2048x1536px · 45-degree field of view.
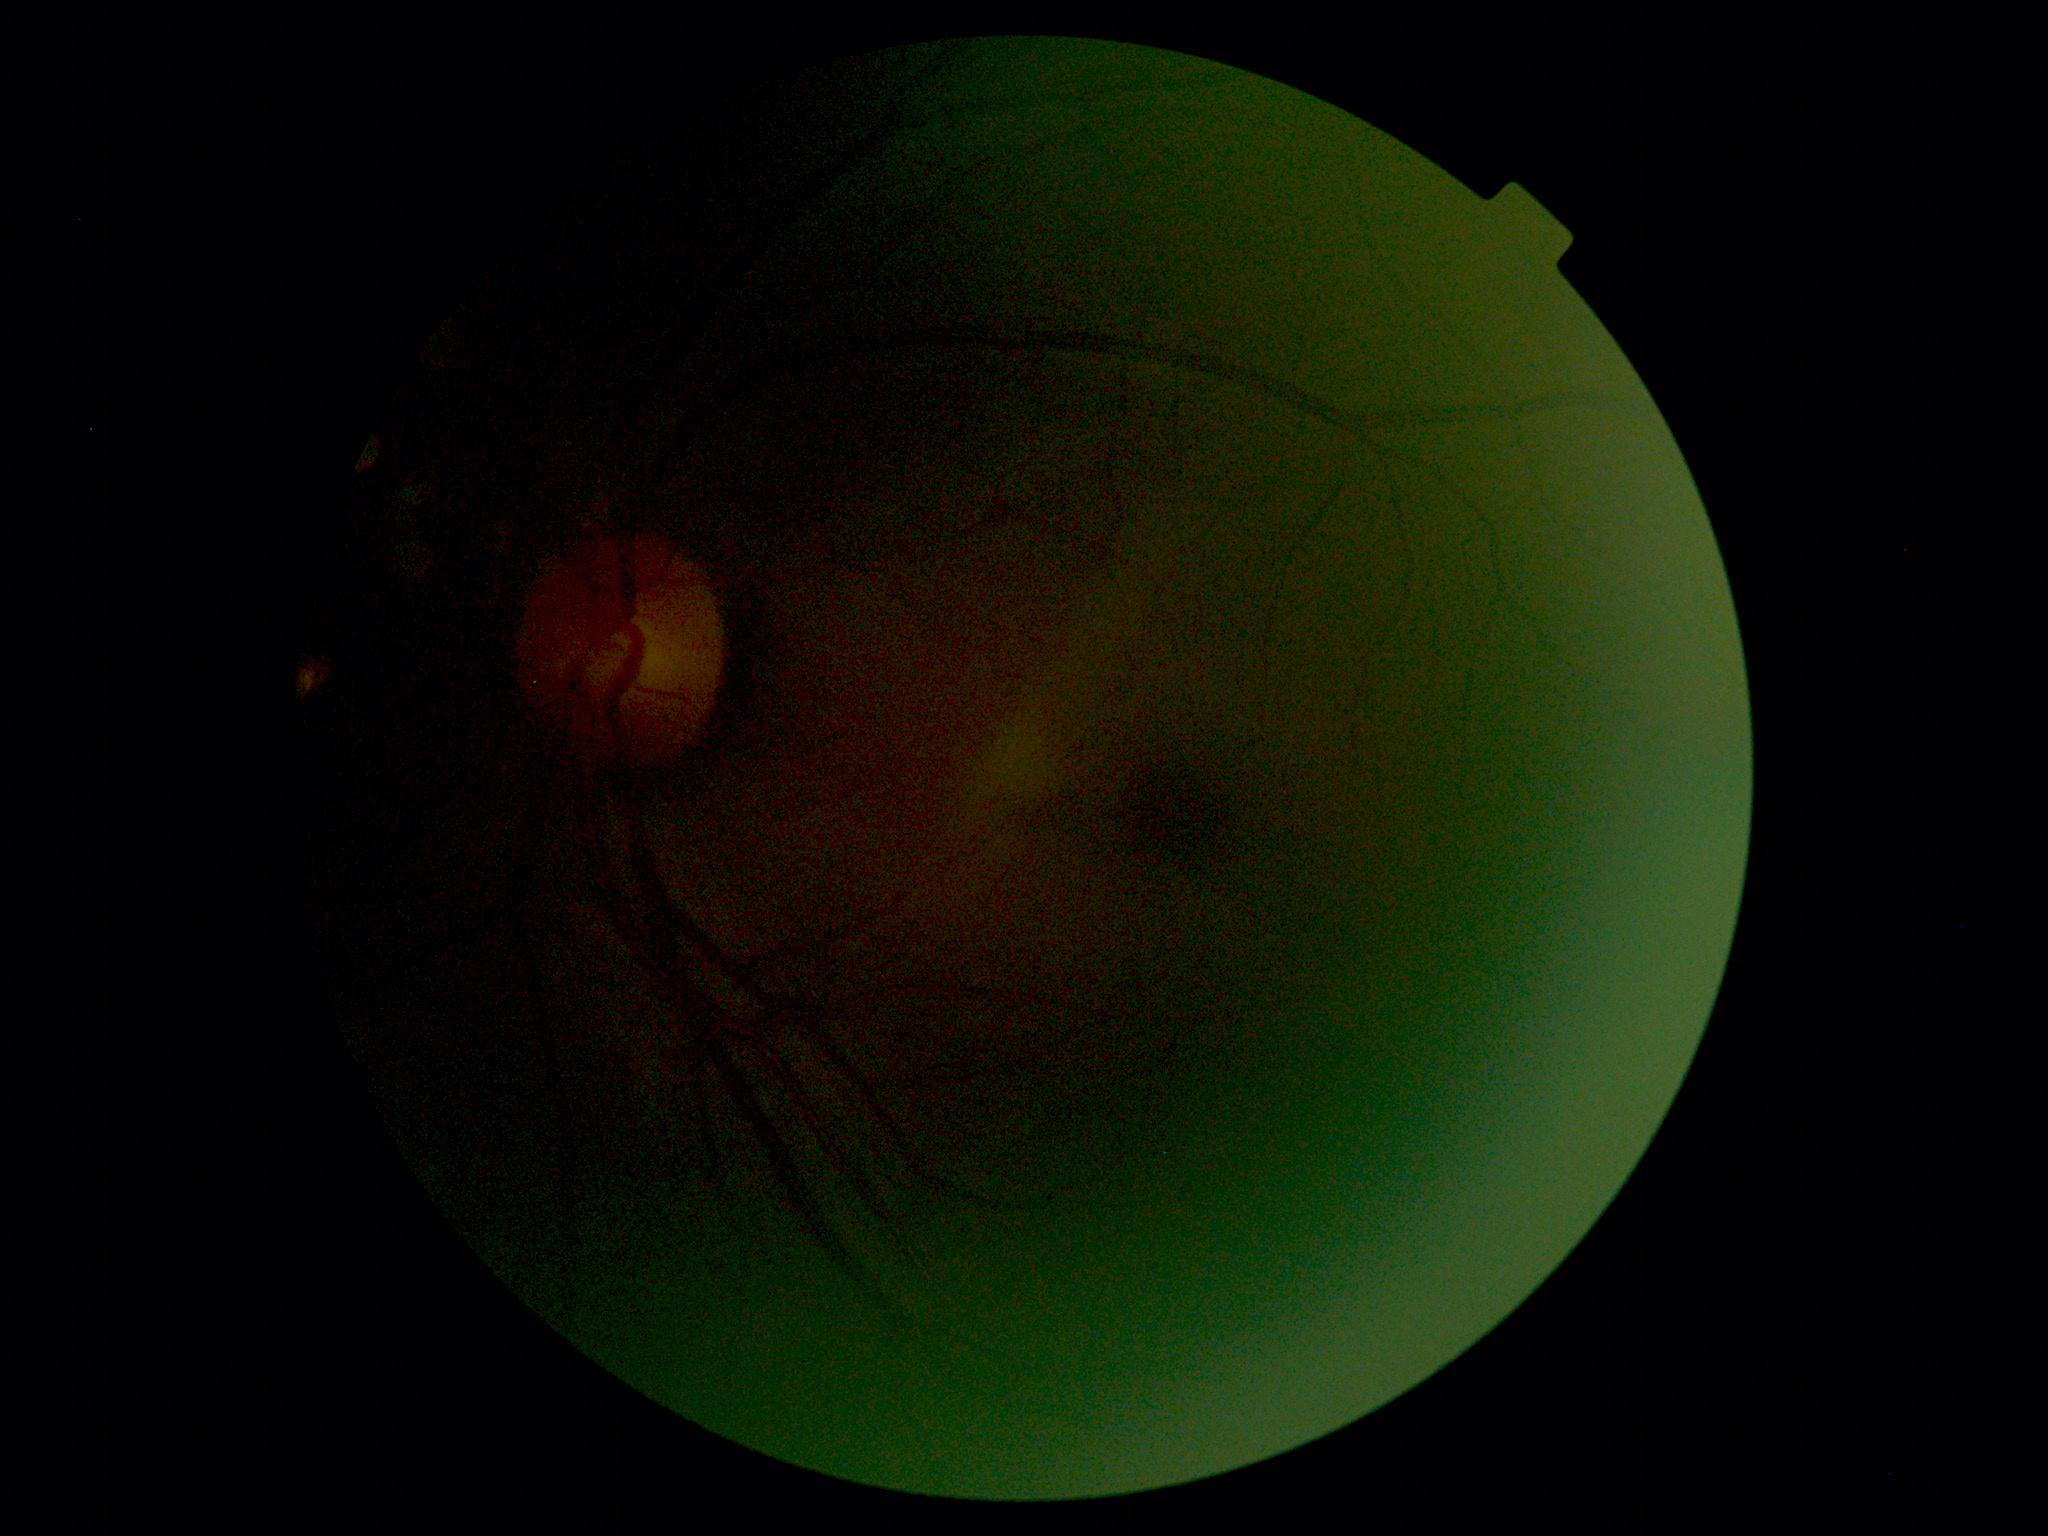 Diabetic retinopathy grade: ungradable due to poor image quality.
Ungradable image — DR severity cannot be determined.